Color fundus photograph: 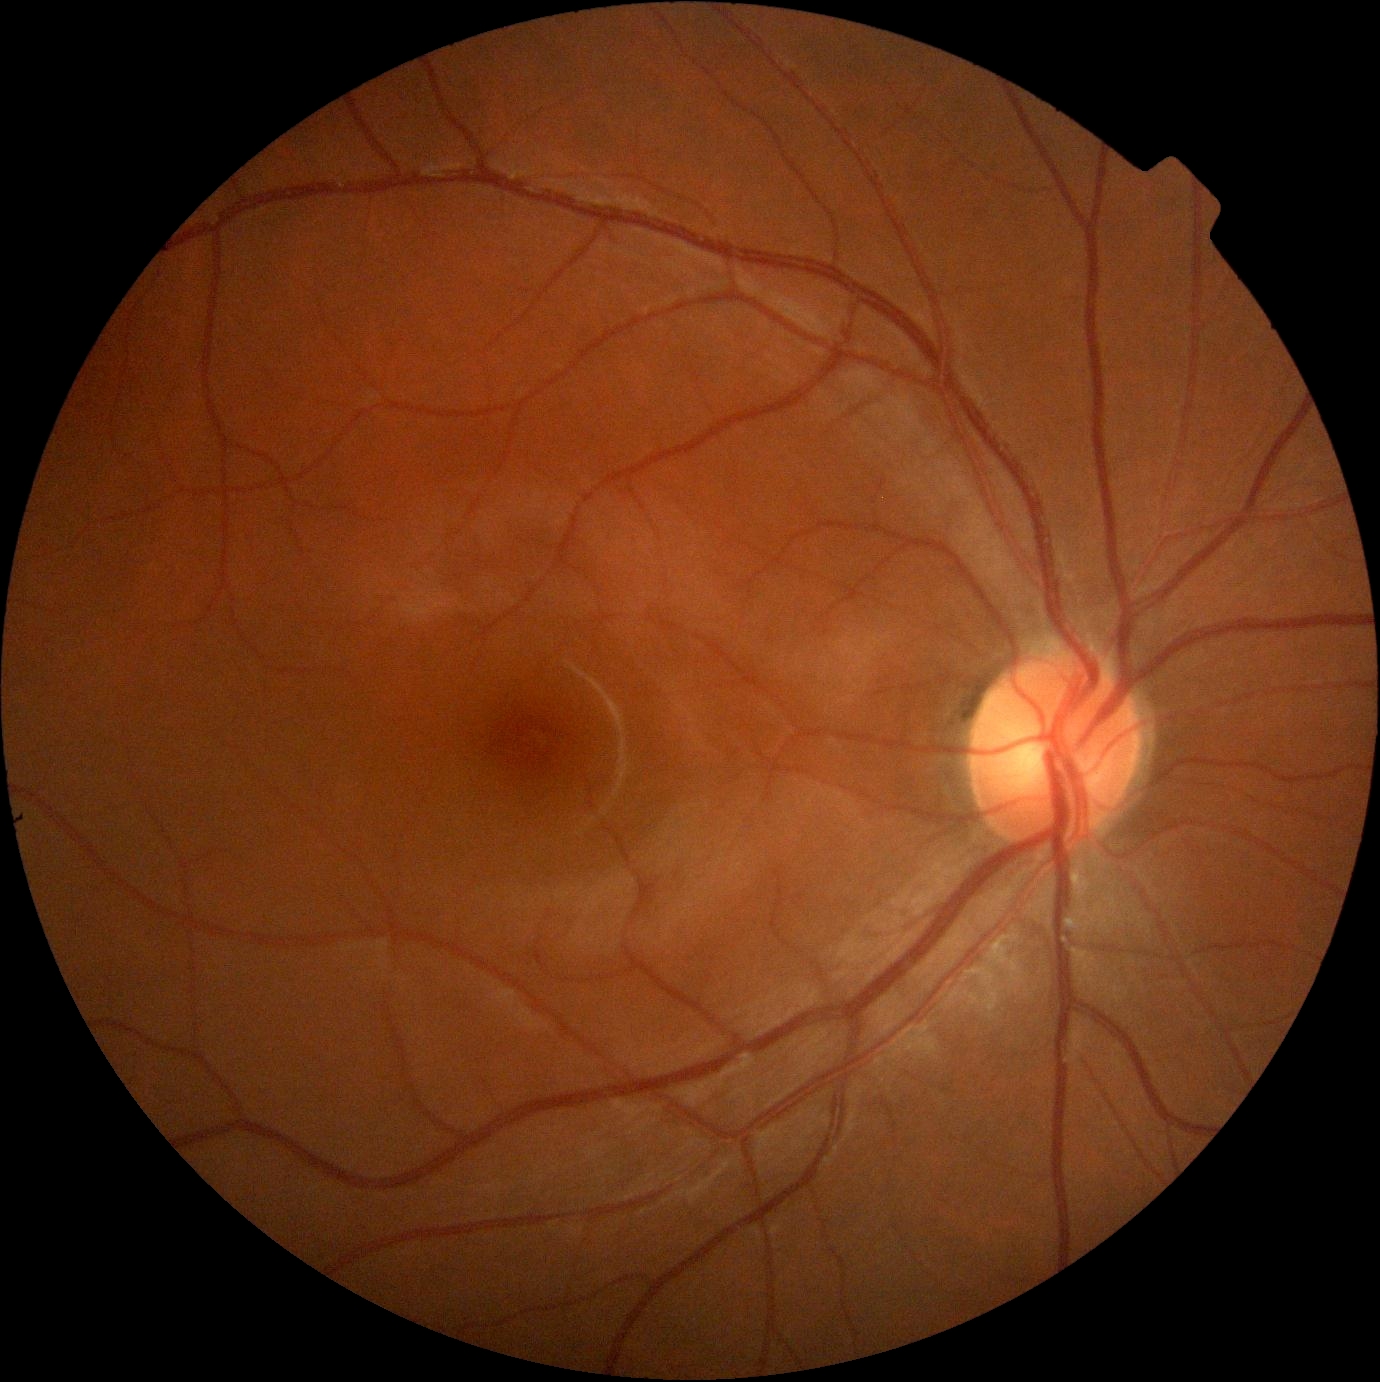

DR severity is no apparent diabetic retinopathy (grade 0).